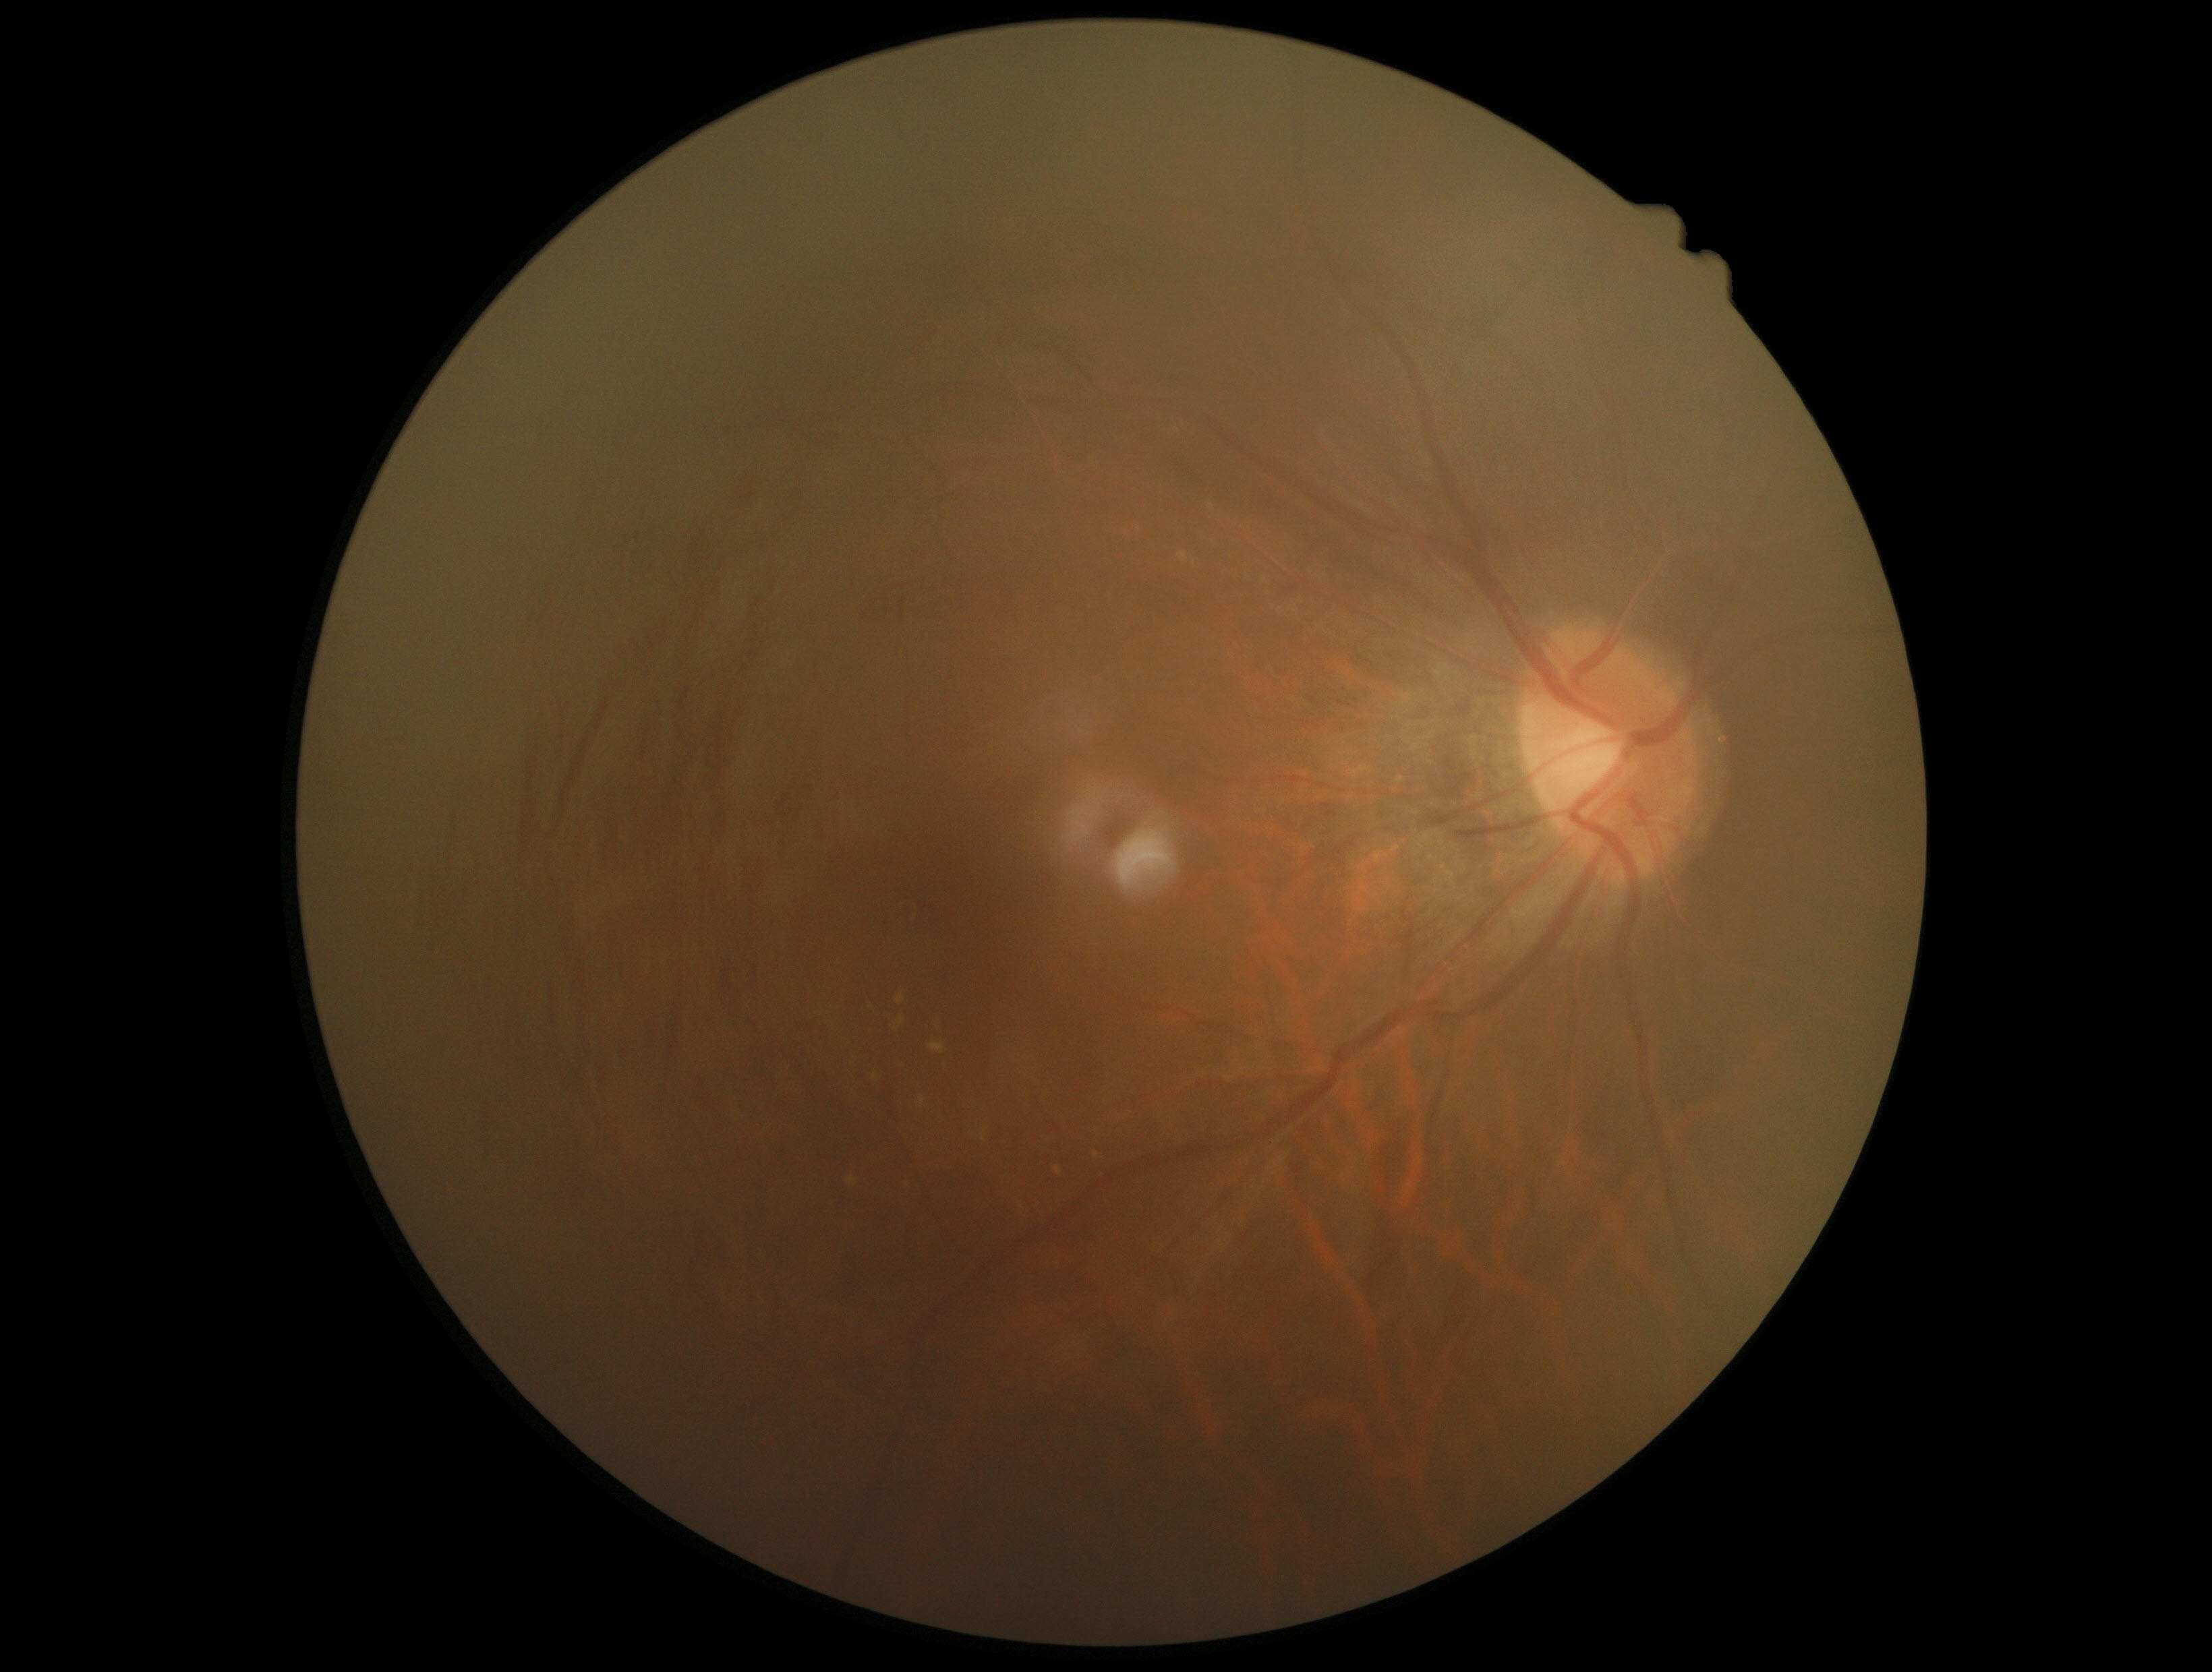
Diabetic retinopathy (DR) is grade 2 (moderate NPDR) — more than just microaneurysms but less than severe NPDR.